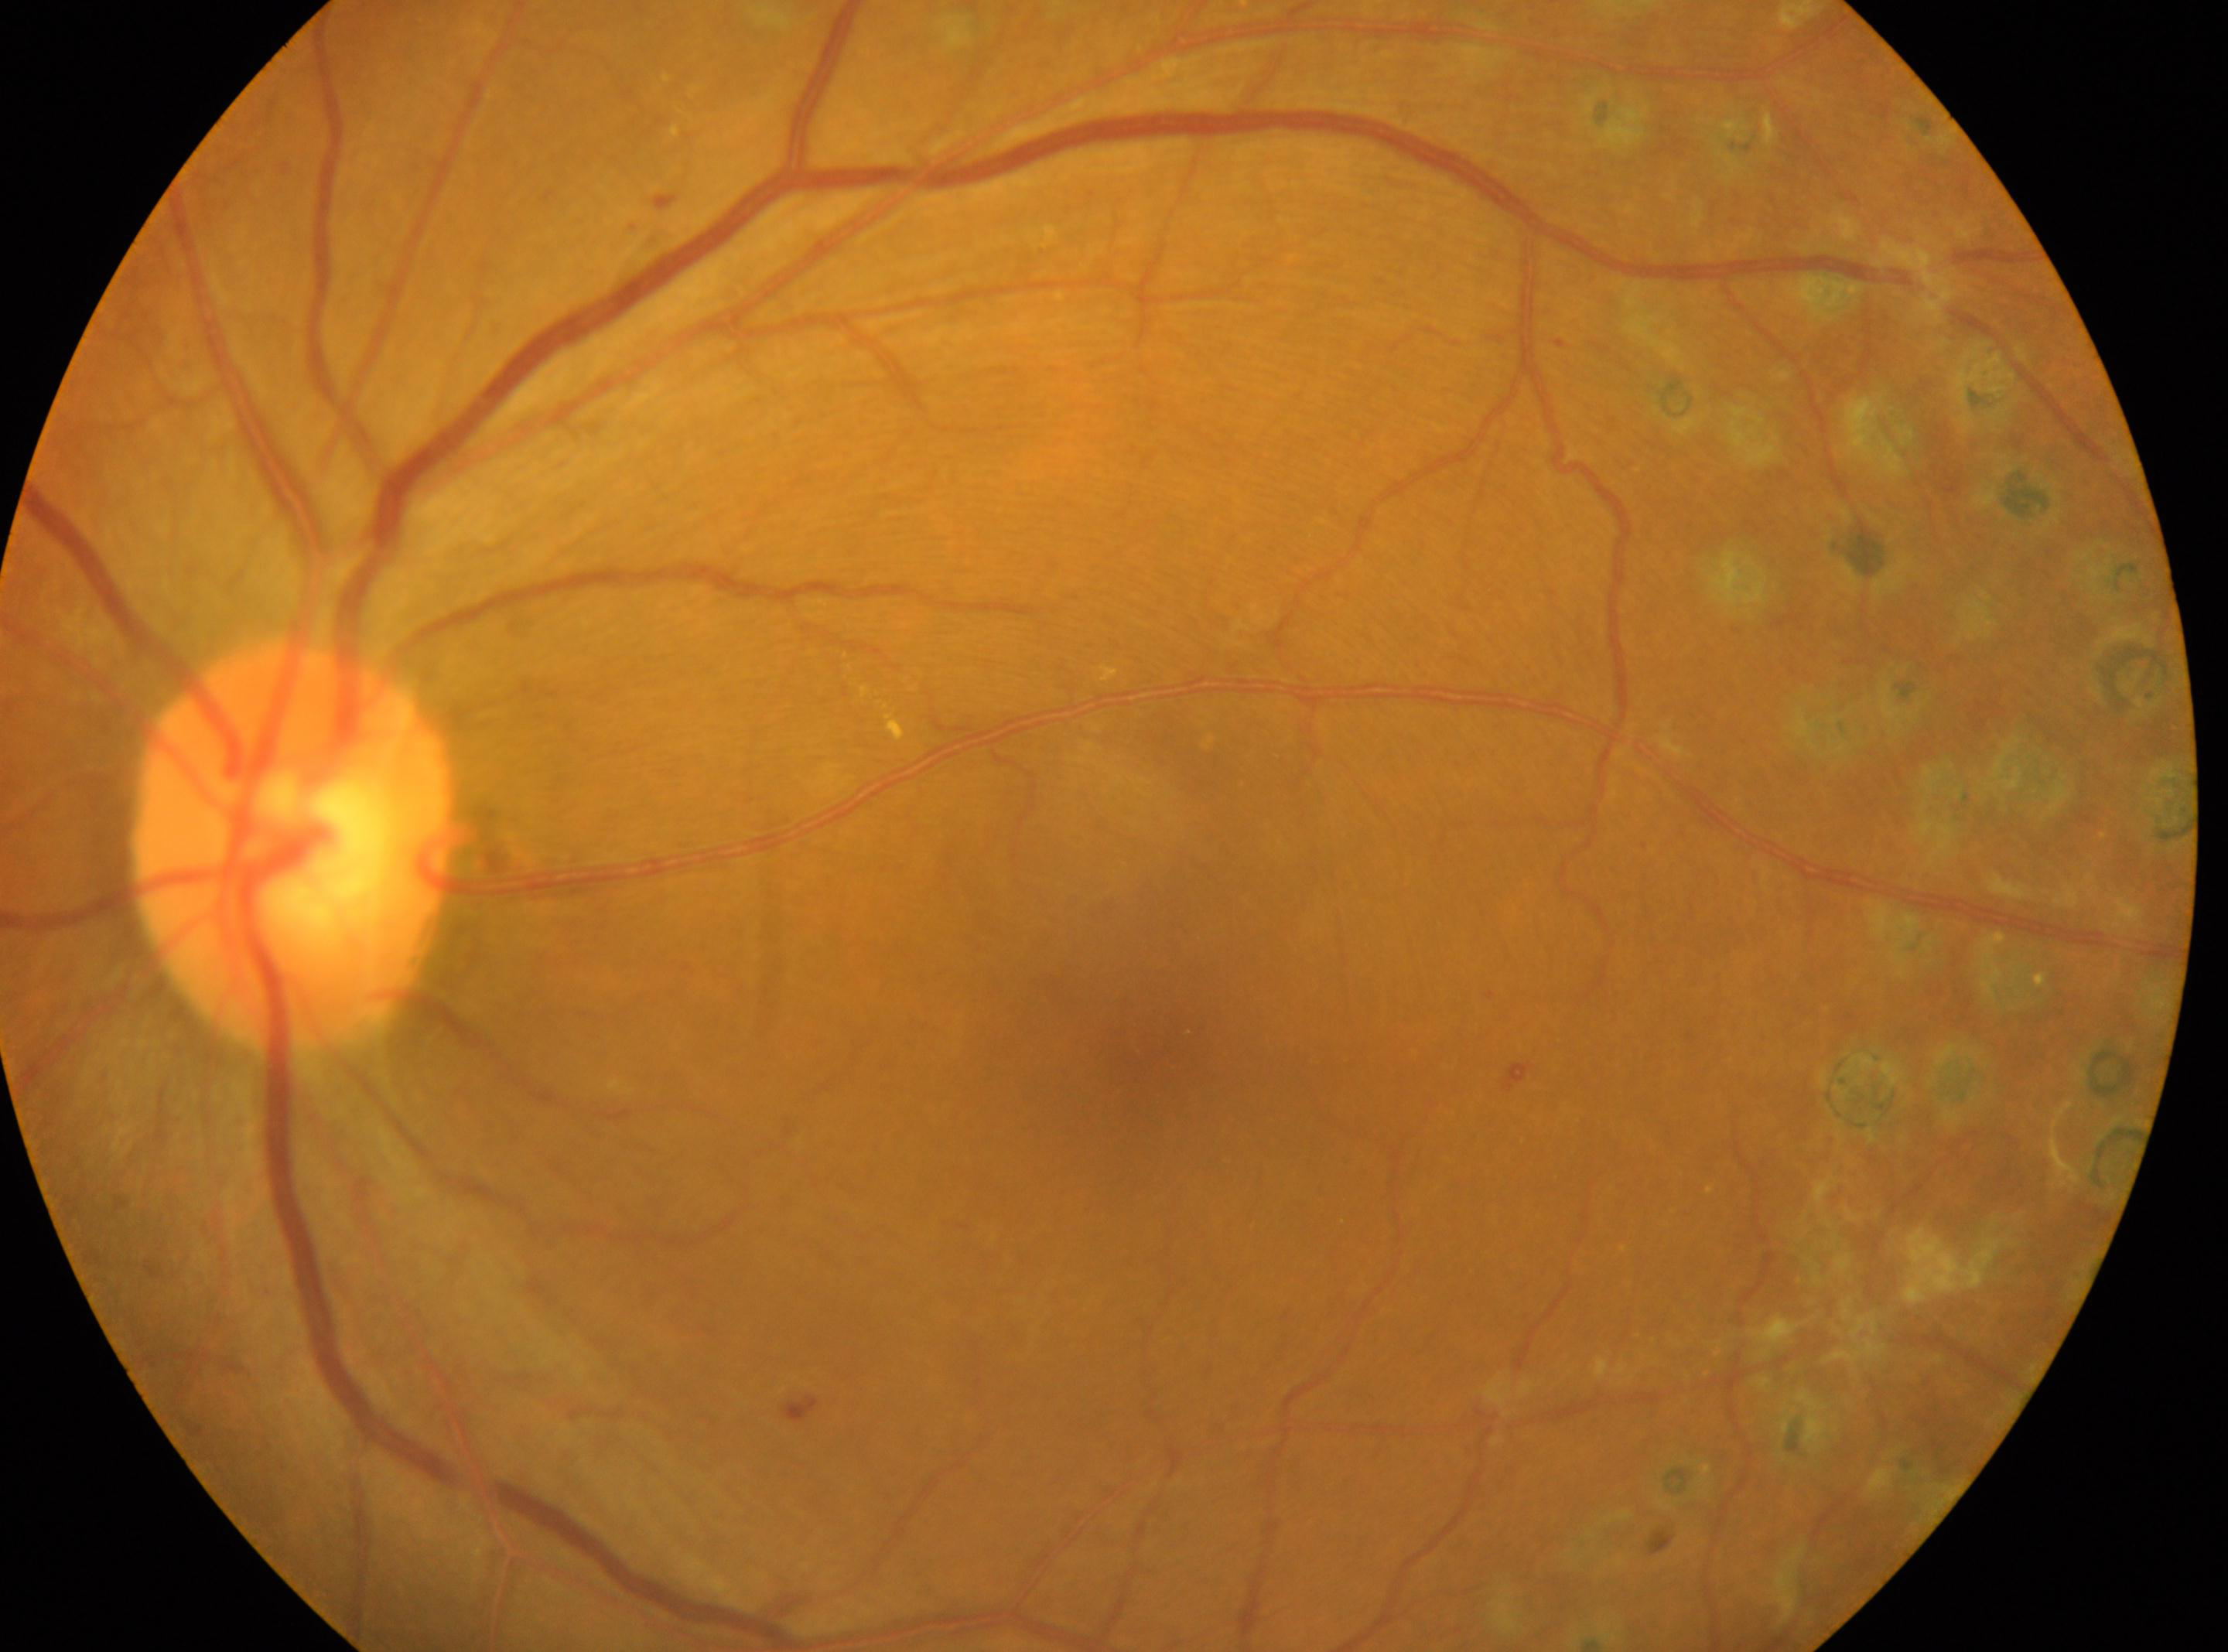

Fovea: 1145px, 1038px. Diabetic retinopathy severity is post-laser DR, reclassified as moderate NPDR (grade 2). The image shows the left eye. ONH located at 292px, 848px.